ONH-centered crop from a color fundus image
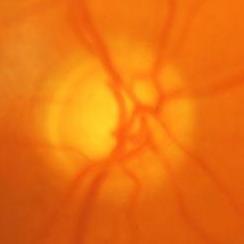 Demonstrates glaucomatous changes.